Posterior pole photograph. 45° field of view. 848 by 848 pixels. Acquired with a NIDEK AFC-230:
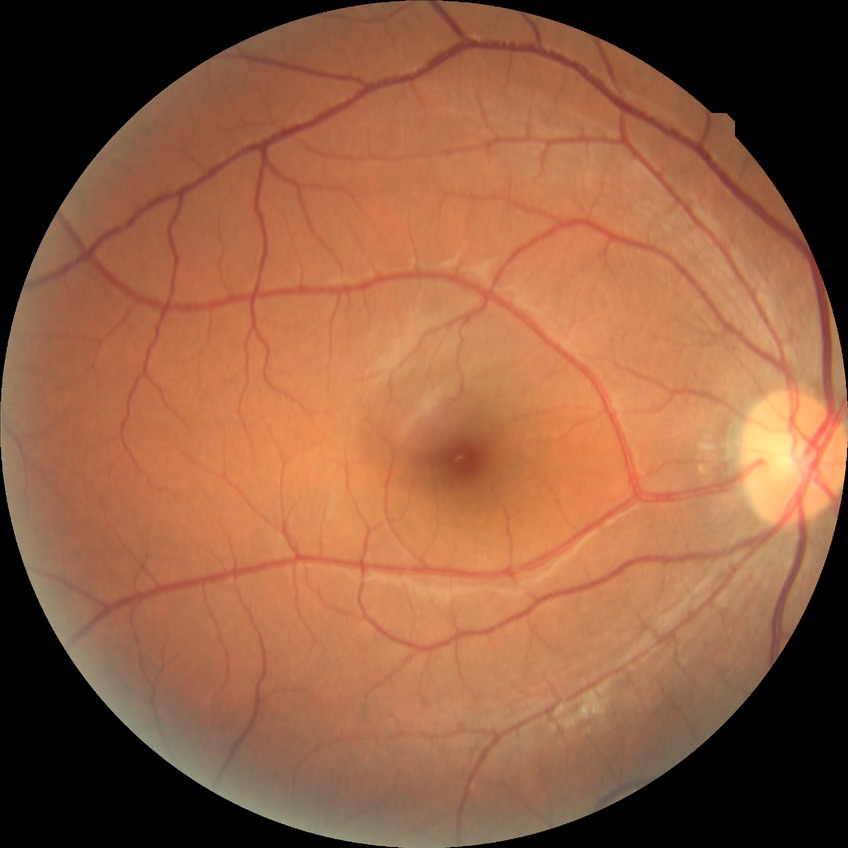 No signs of diabetic retinopathy. Modified Davis grade is NDR.